848 by 848 pixels. Modified Davis classification: 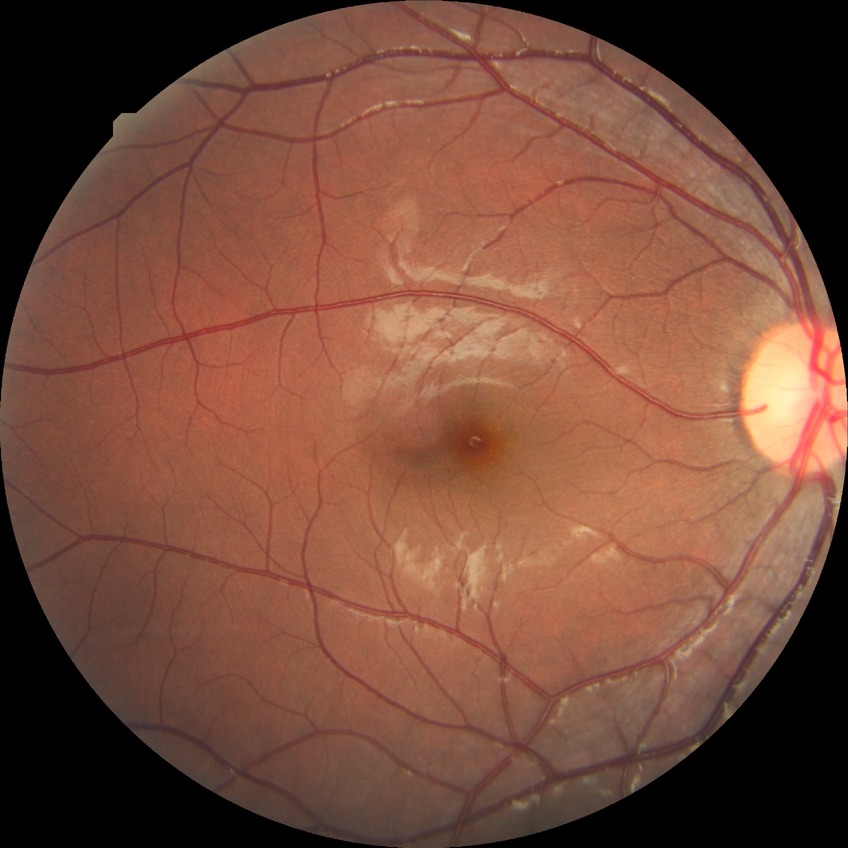
davis_grade: no diabetic retinopathy (NDR)